Fundus photo. FOV: 45 degrees:
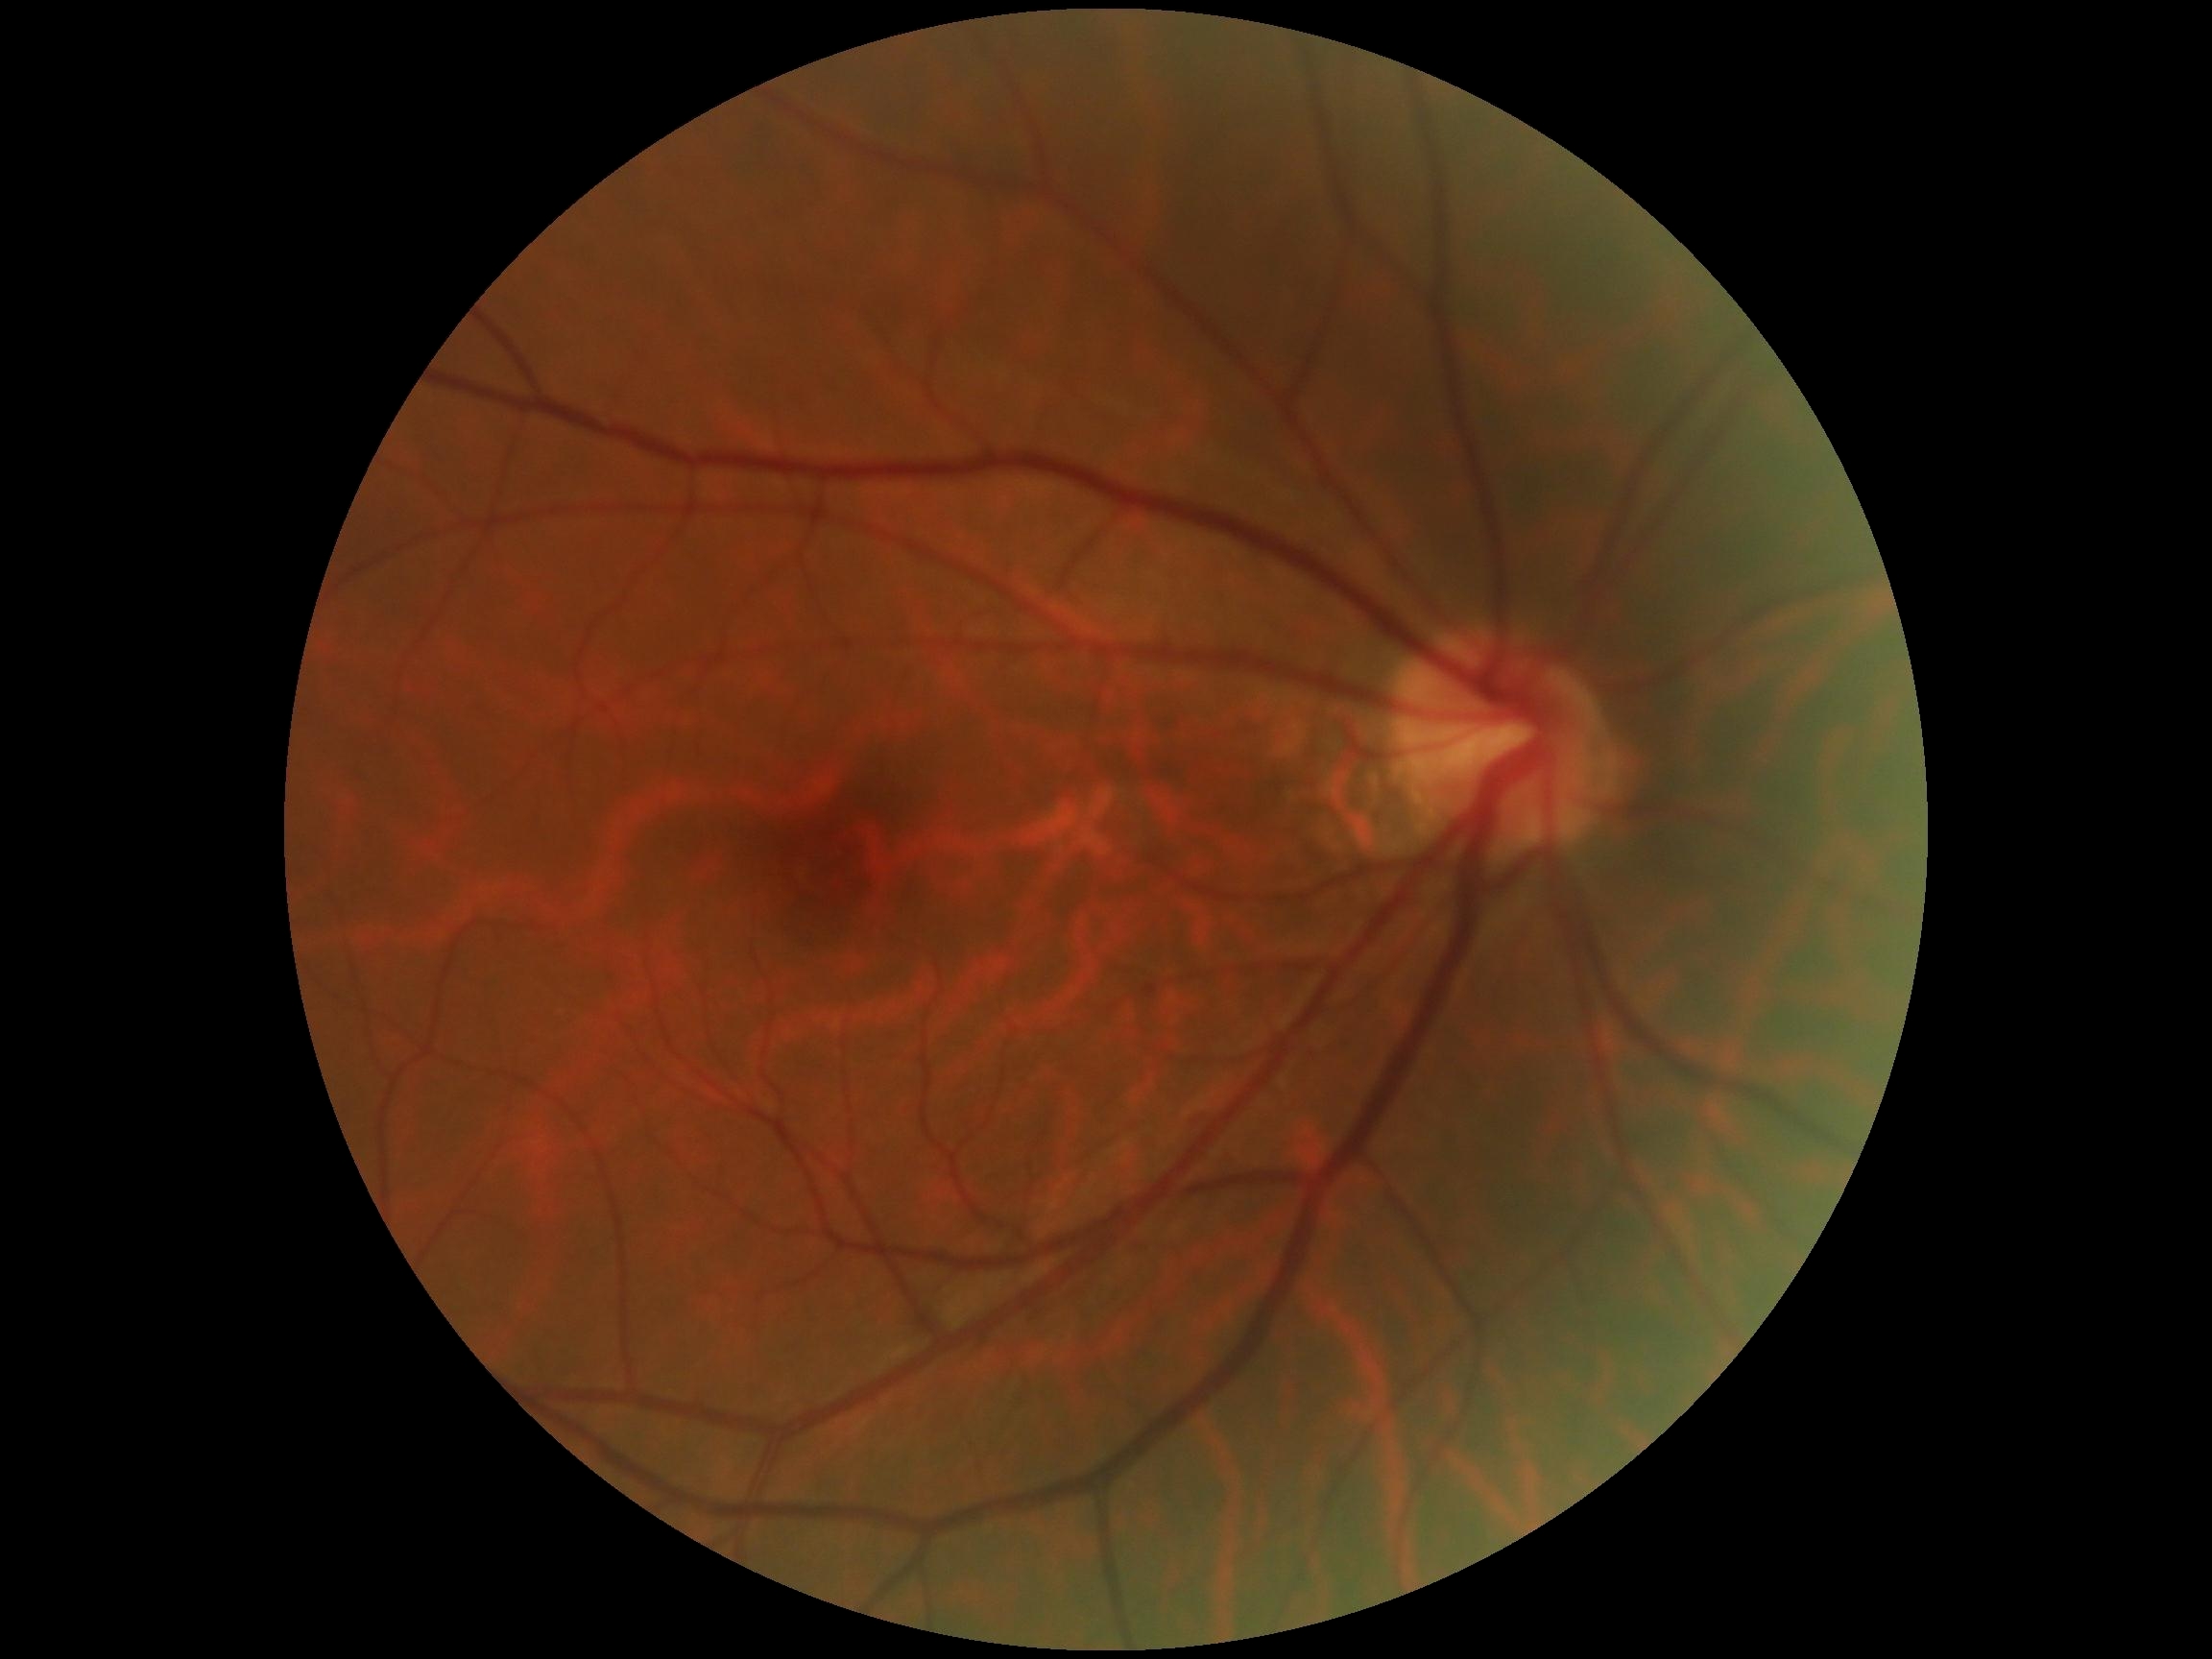 Diabetic retinopathy (DR) is 0/4.